Fundus photo
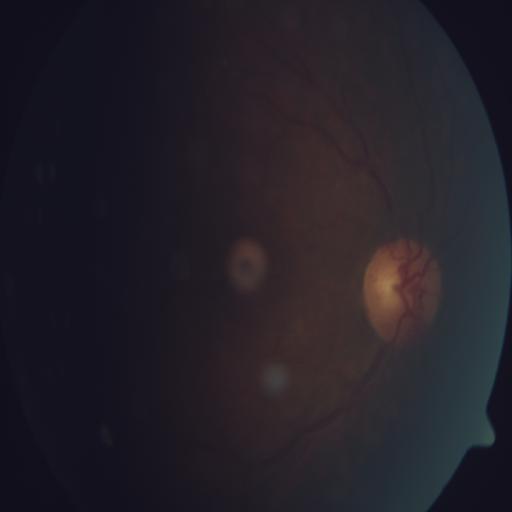
Showing chorioretinitis (CRS).